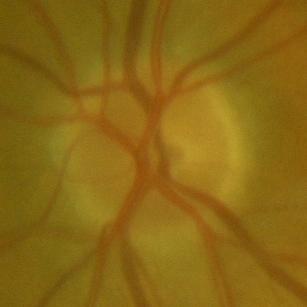
Consistent with no evidence of glaucoma.